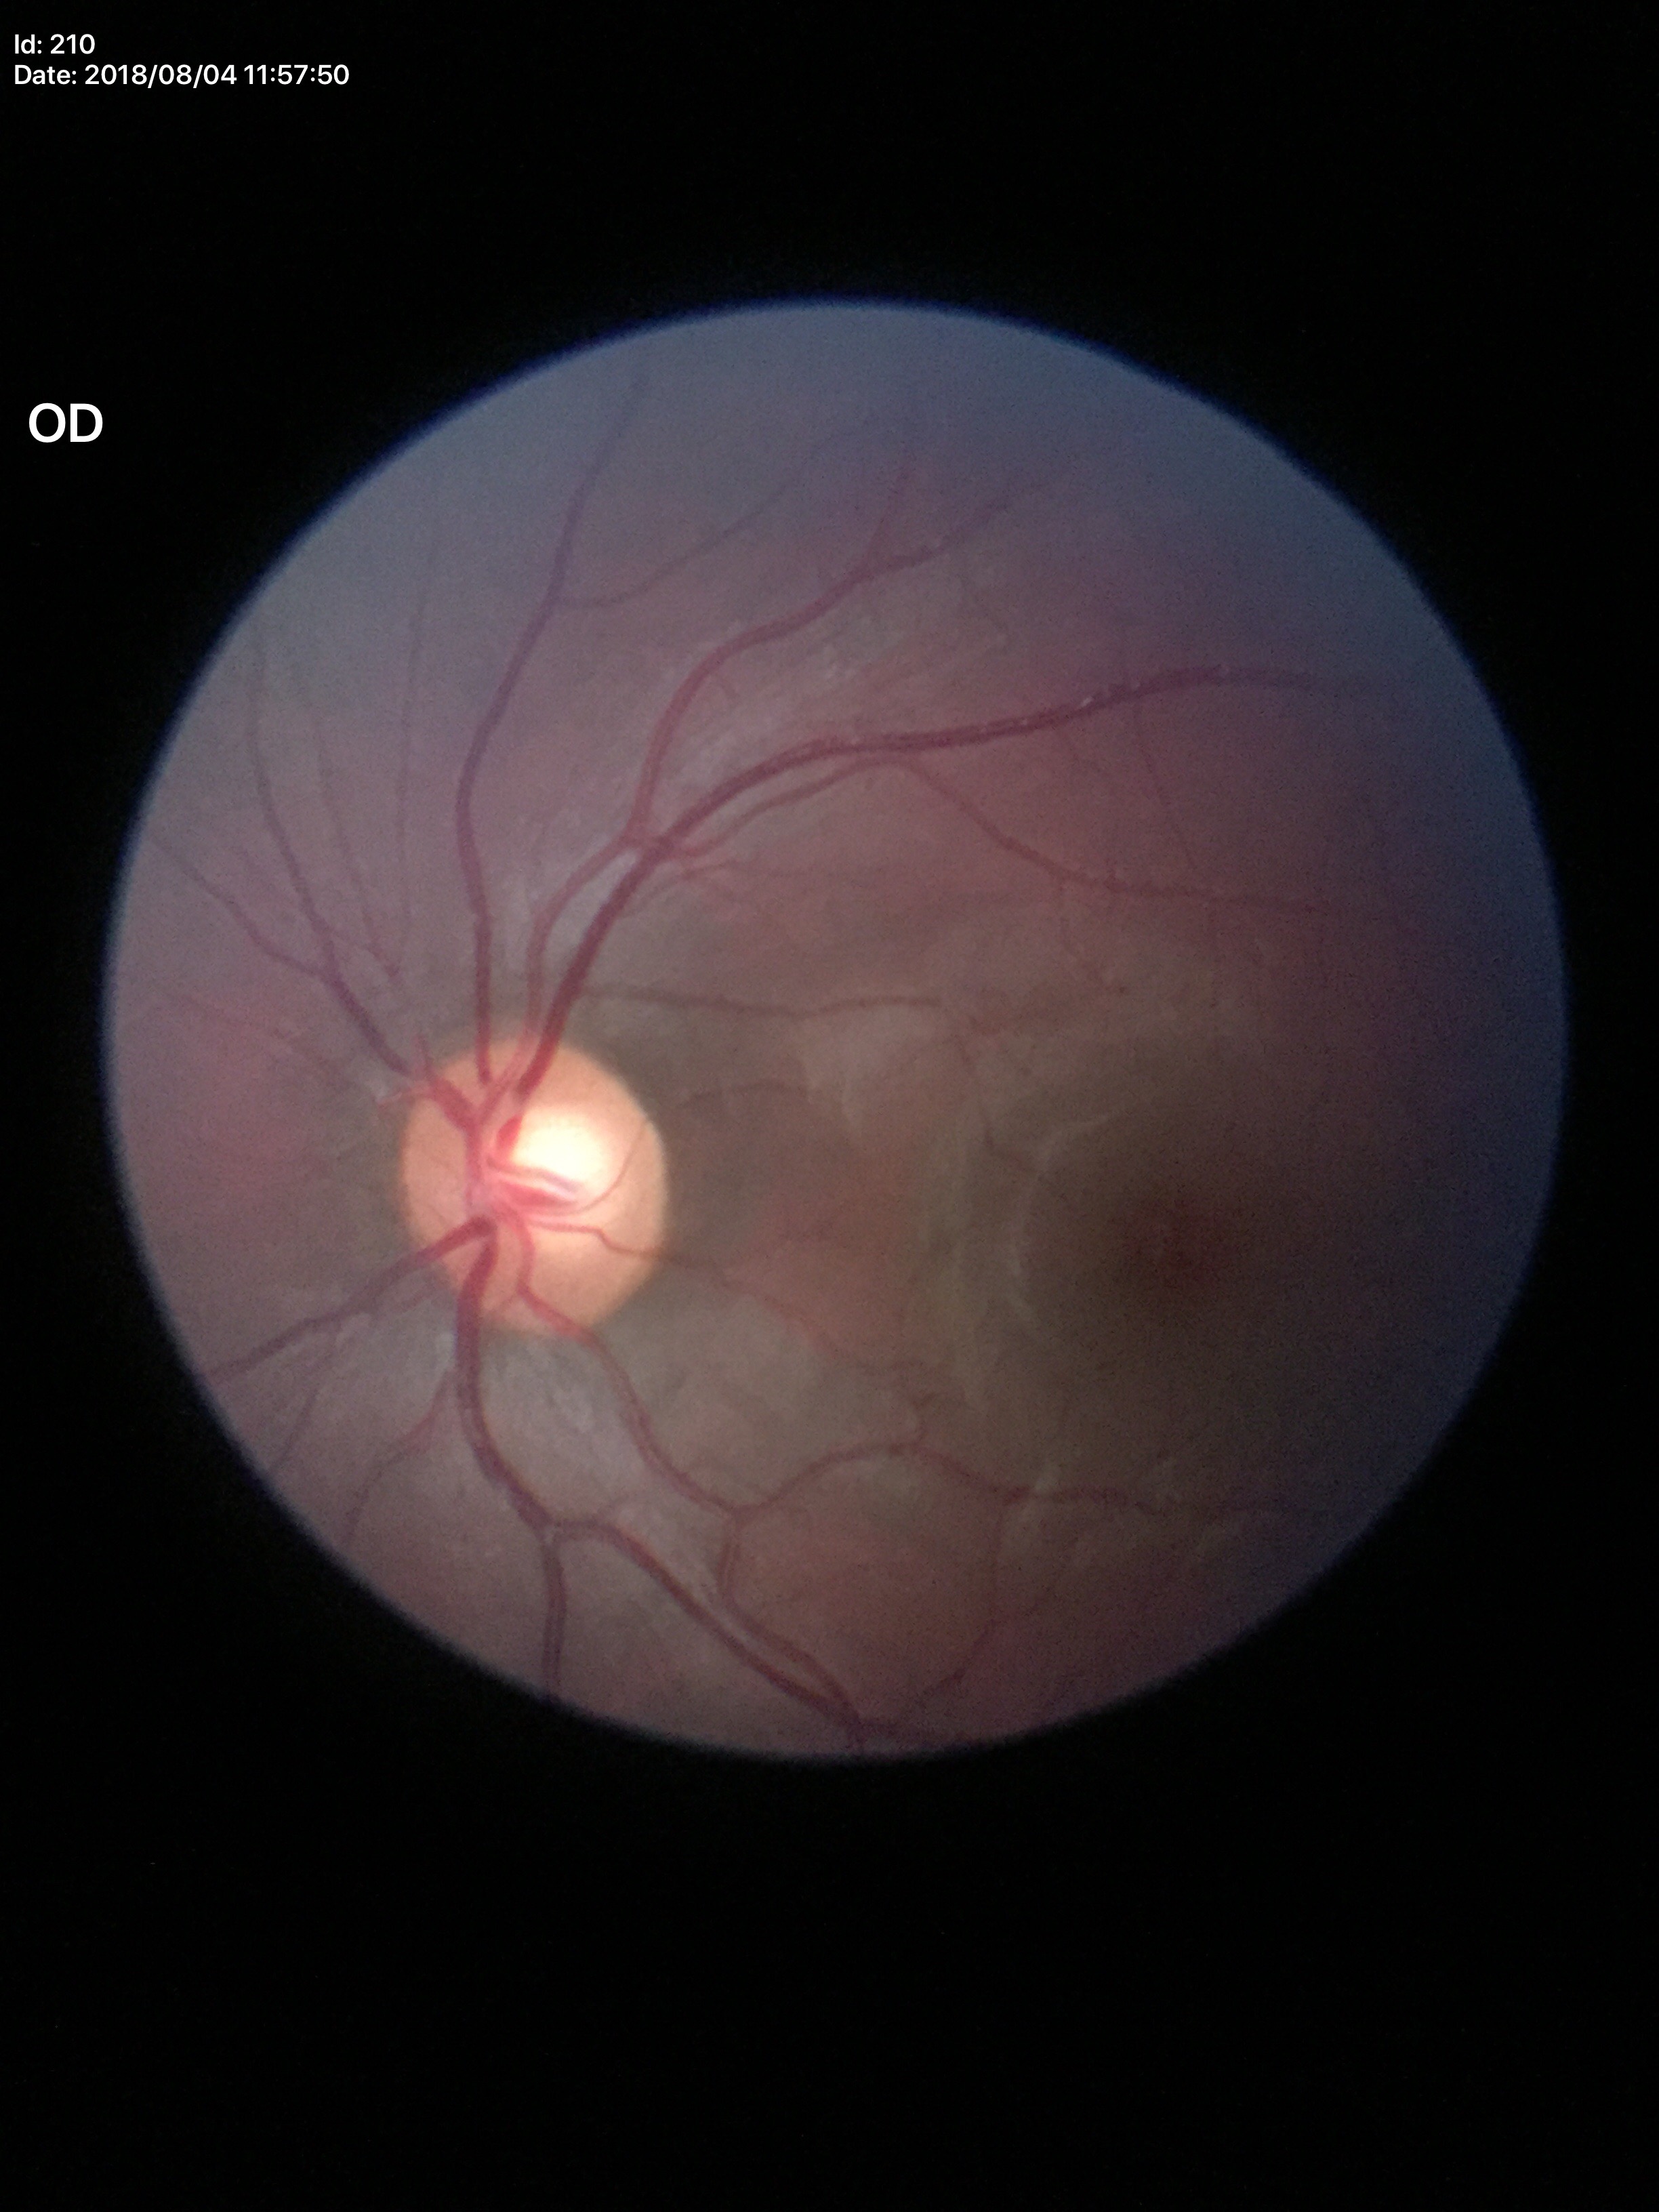
No evidence of glaucoma (1/5 graders called glaucoma suspect). Vertical CDR is 0.61.